No pharmacologic dilation; 45° FOV — 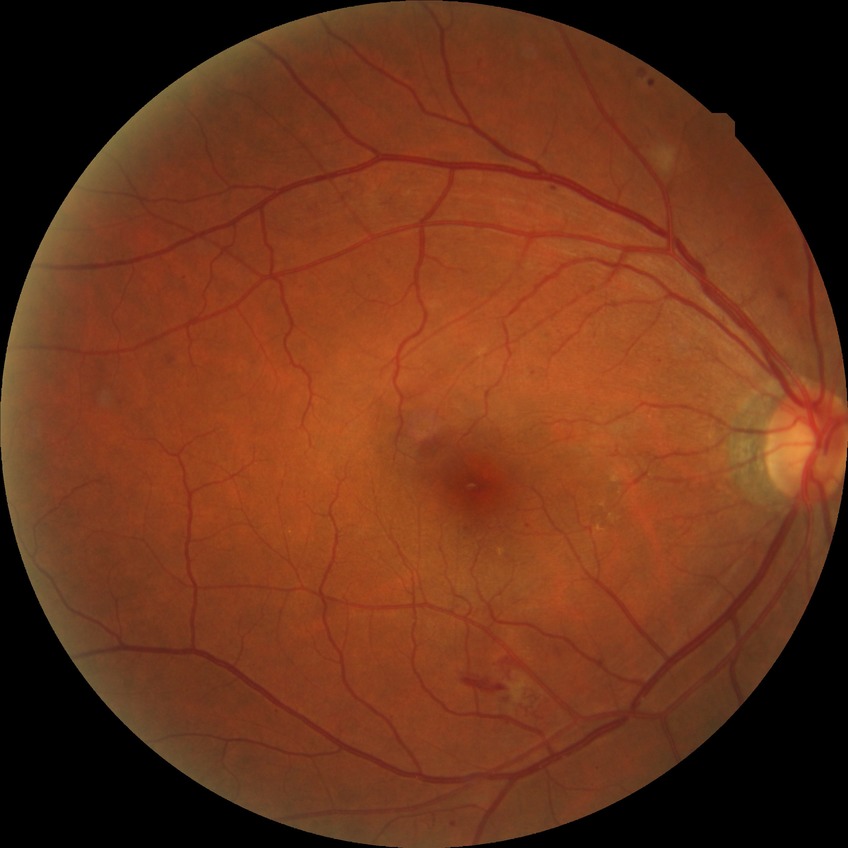
  davis_grade: simple diabetic retinopathy (SDR)